Graded on the modified Davis scale — 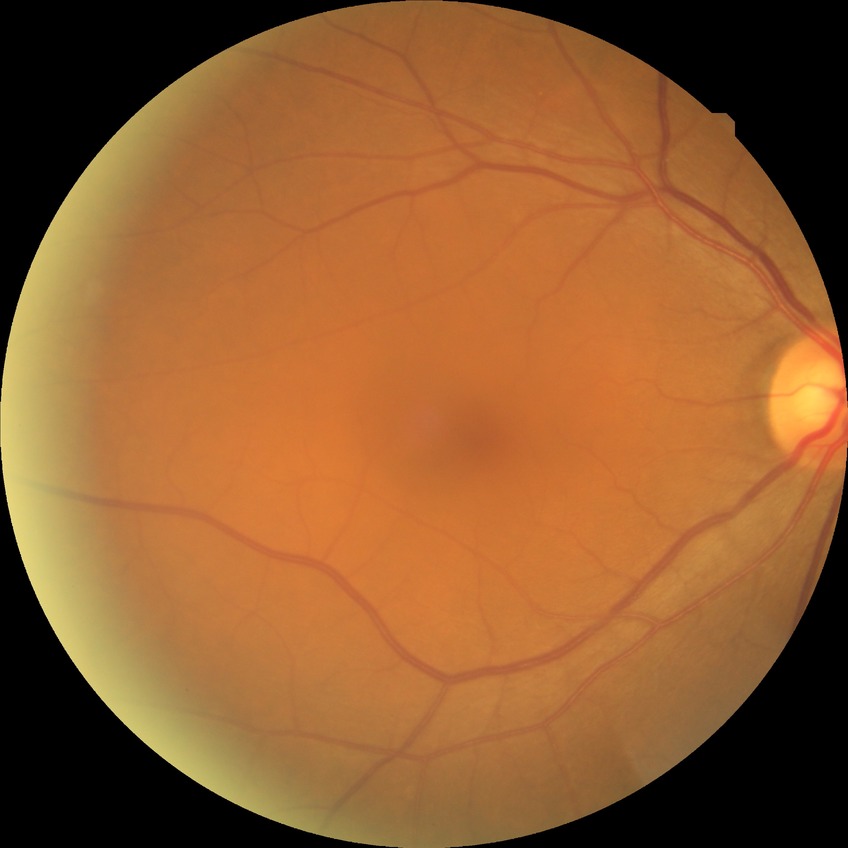

Davis grading is no diabetic retinopathy.